FOV: 30 degrees · centered on the optic disc · color fundus image — 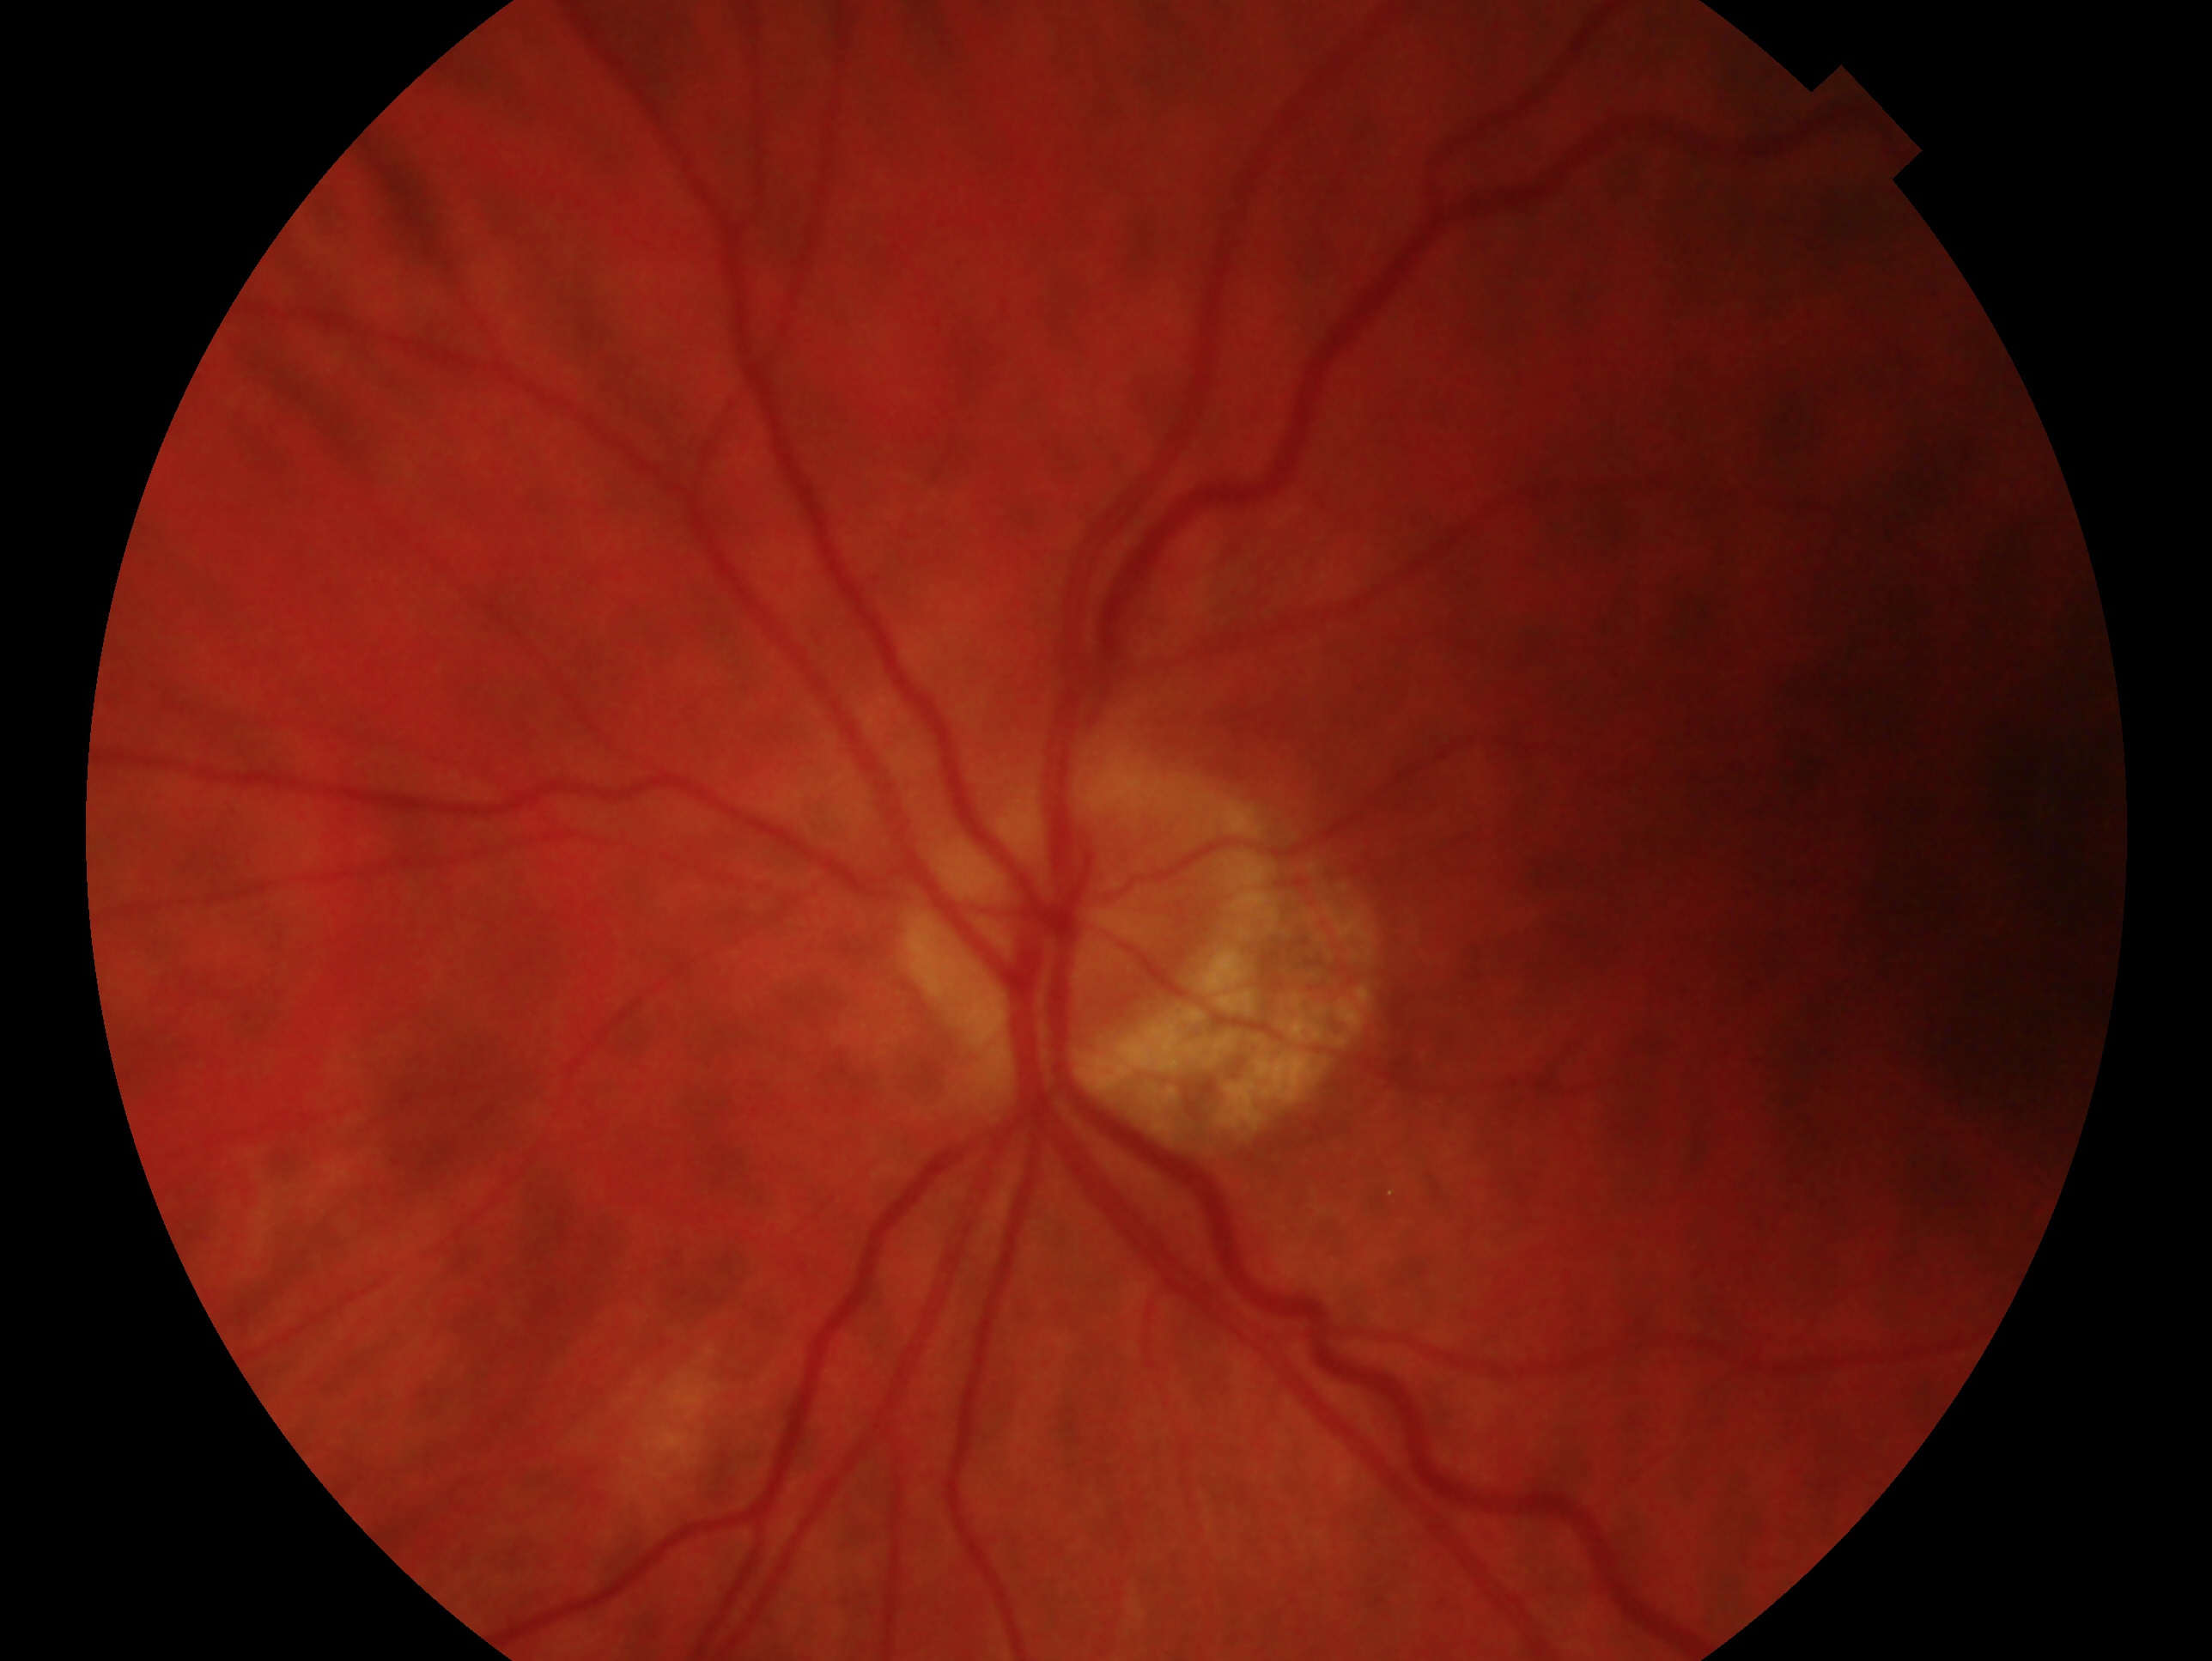
The image shows the left eye. Glaucoma diagnosis: no evidence of glaucoma.